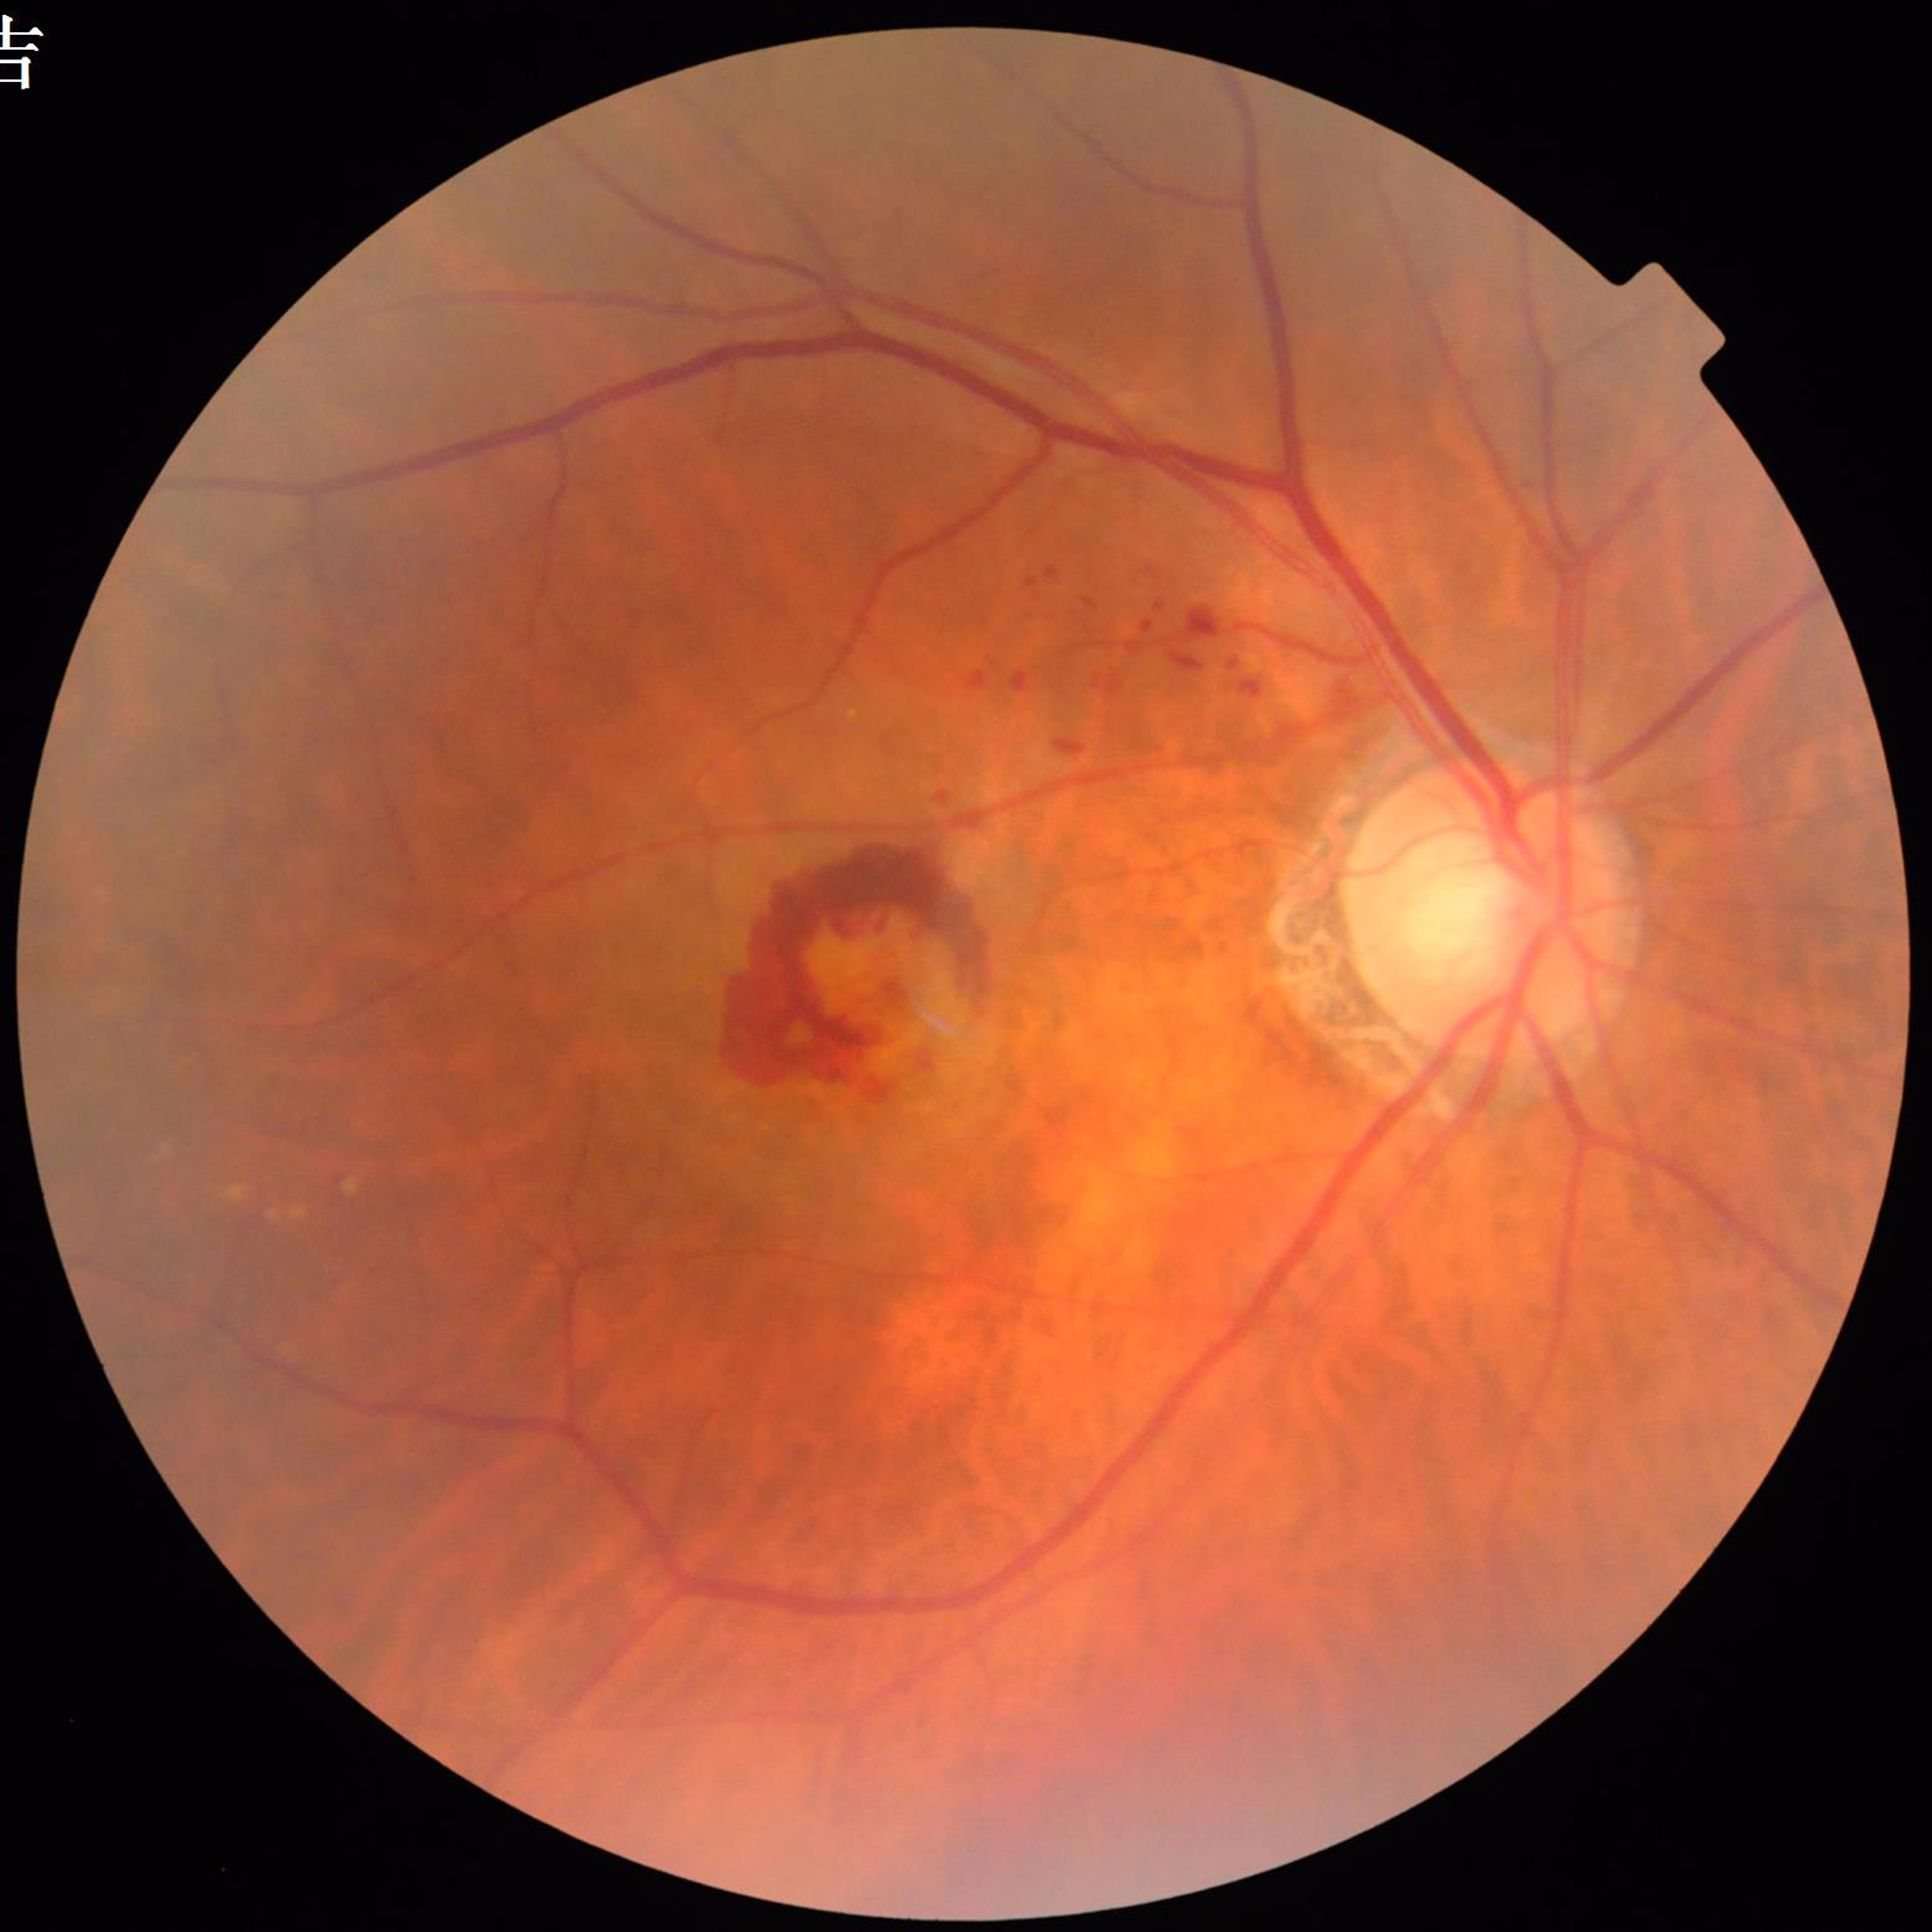 Quality assessment: satisfactory; Impression: AMD.